Wide-field contact fundus photograph of an infant: 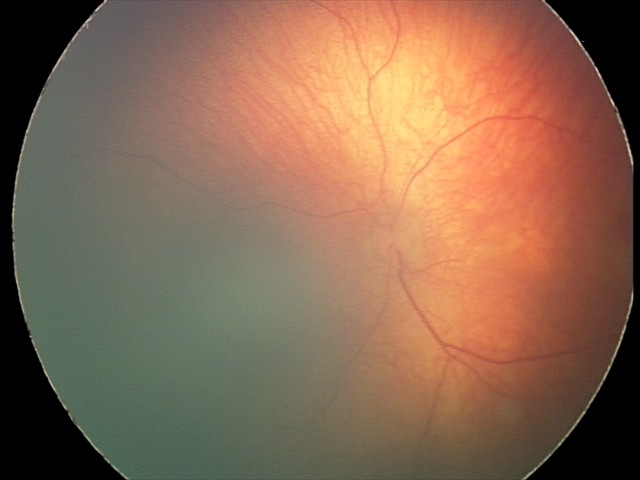

Screening diagnosis: no pathology identified.